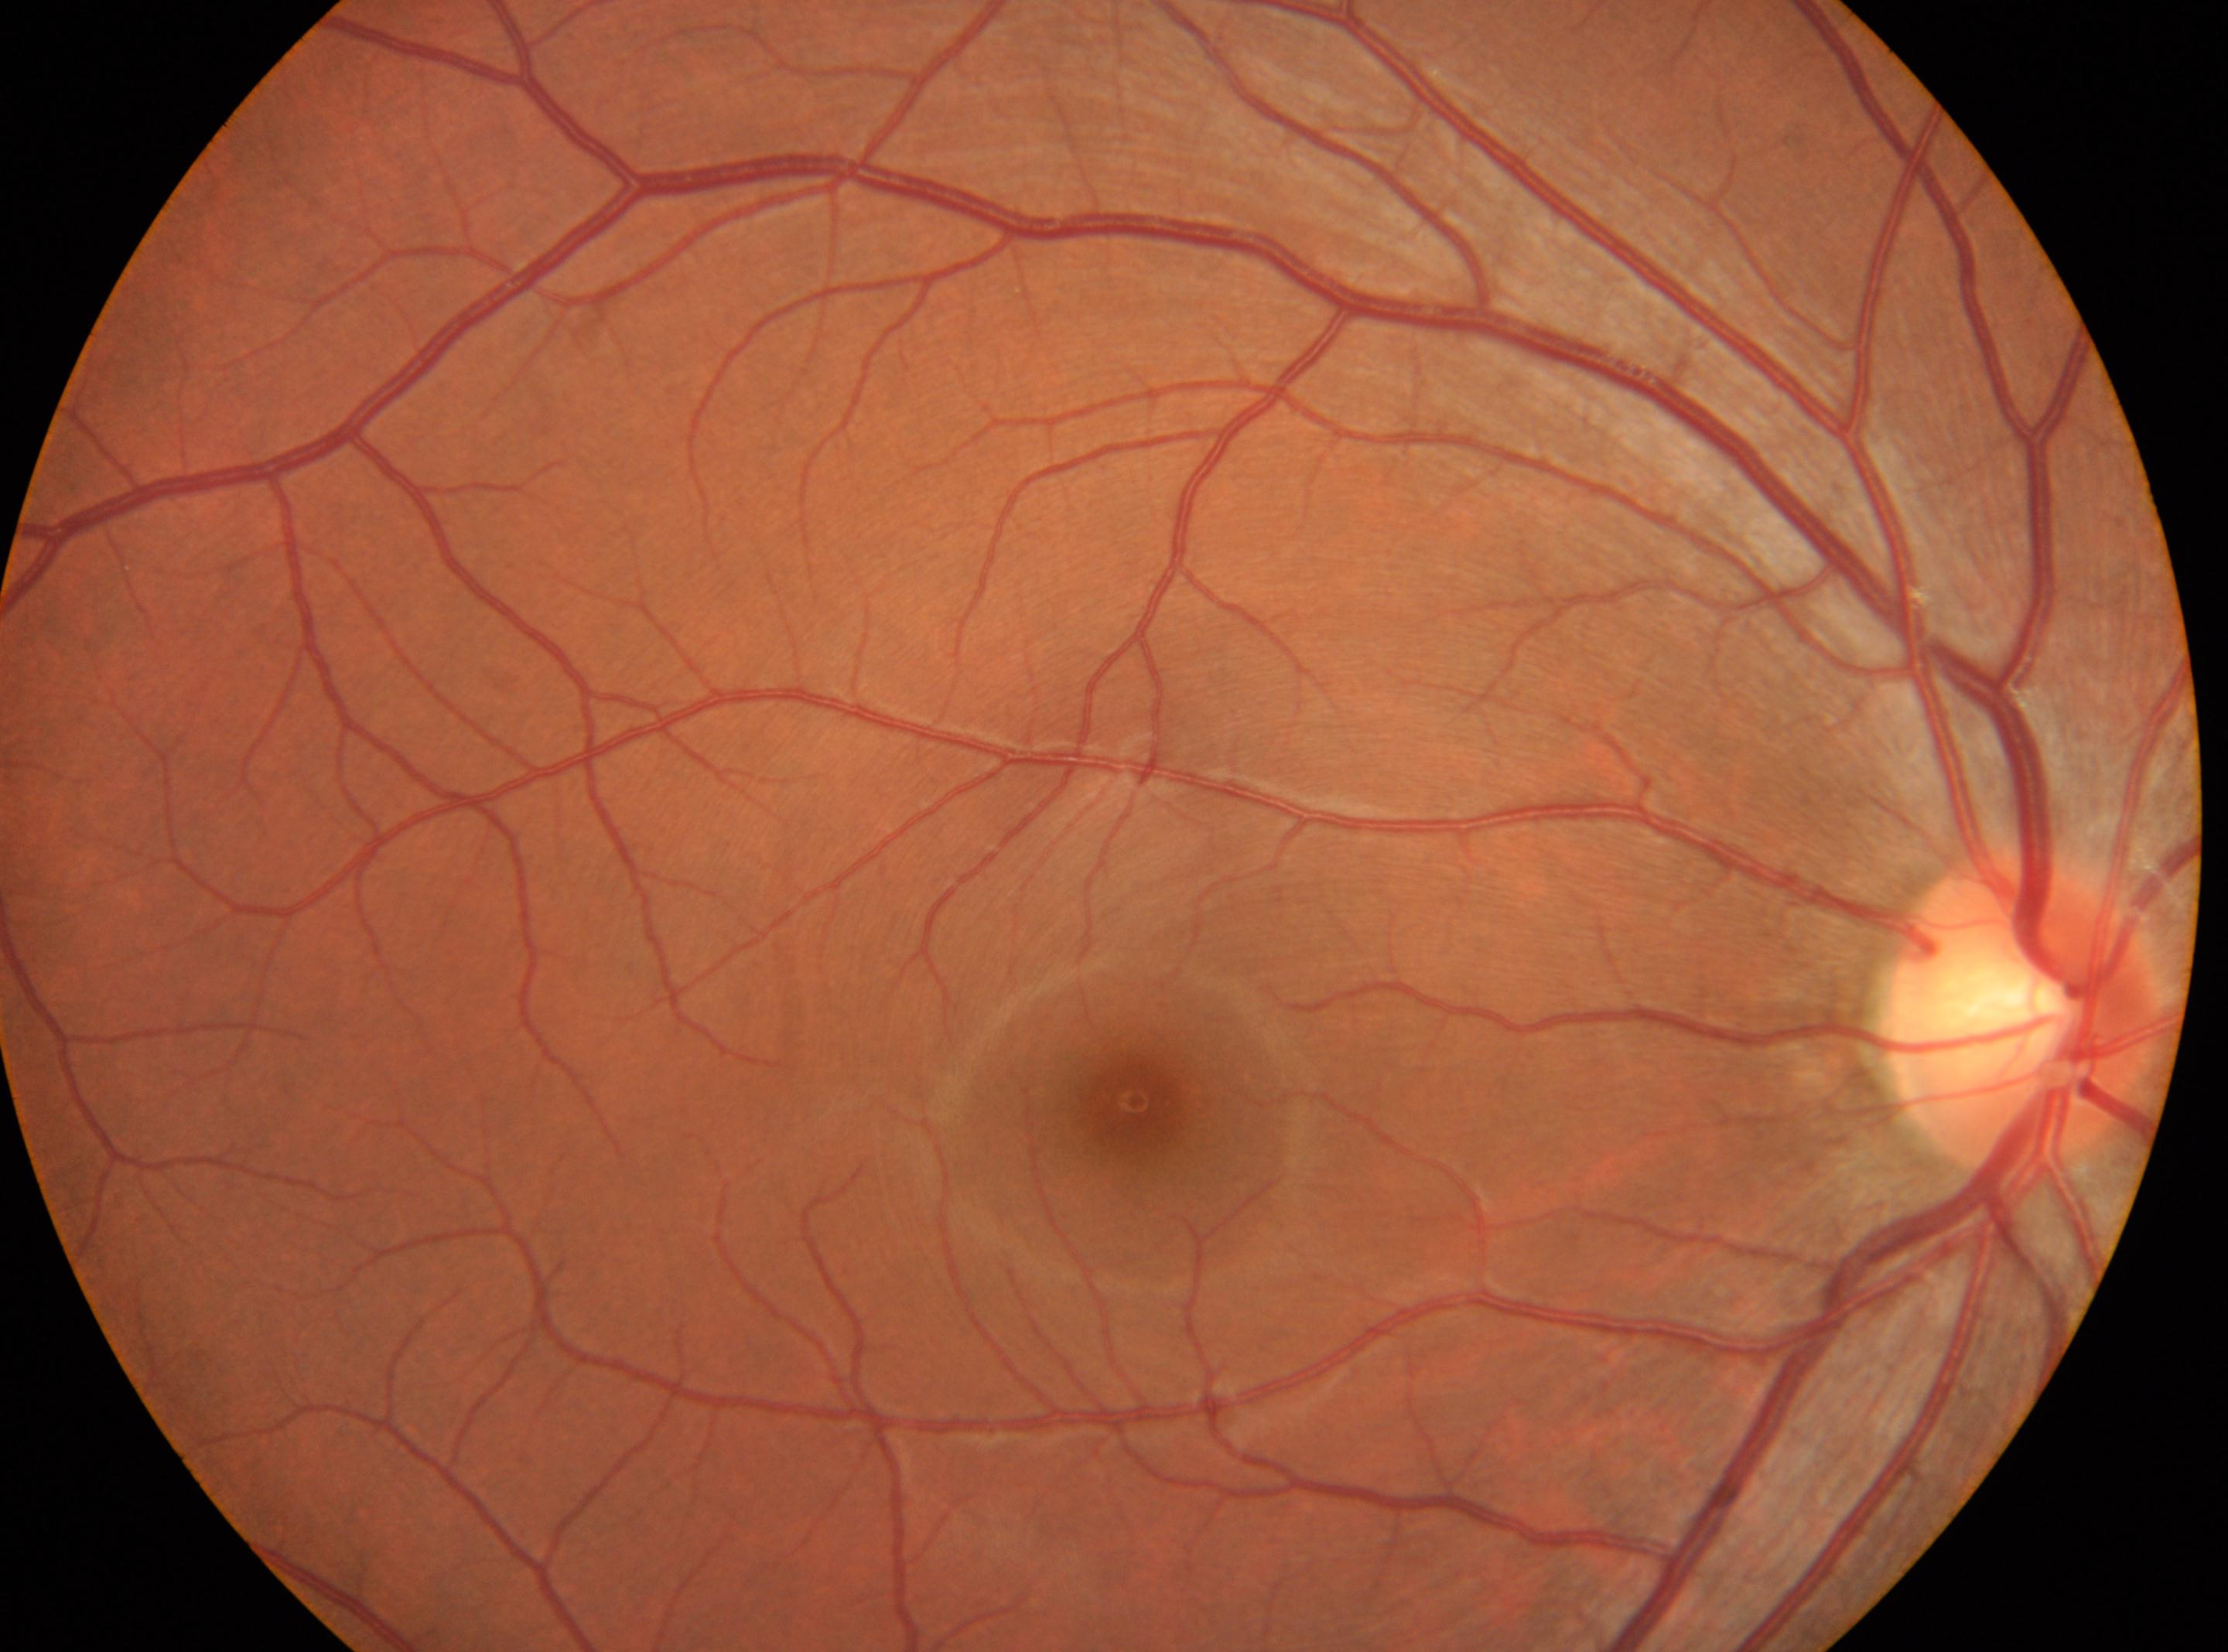 | feature | annotation |
|---|---|
| fovea centralis | (x=1133, y=1100) |
| laterality | oculus dexter |
| diabetic retinopathy | 0 |
| DR impression | No diabetic retinal disease findings |
| disc center | (x=2023, y=1012) |